CFP — 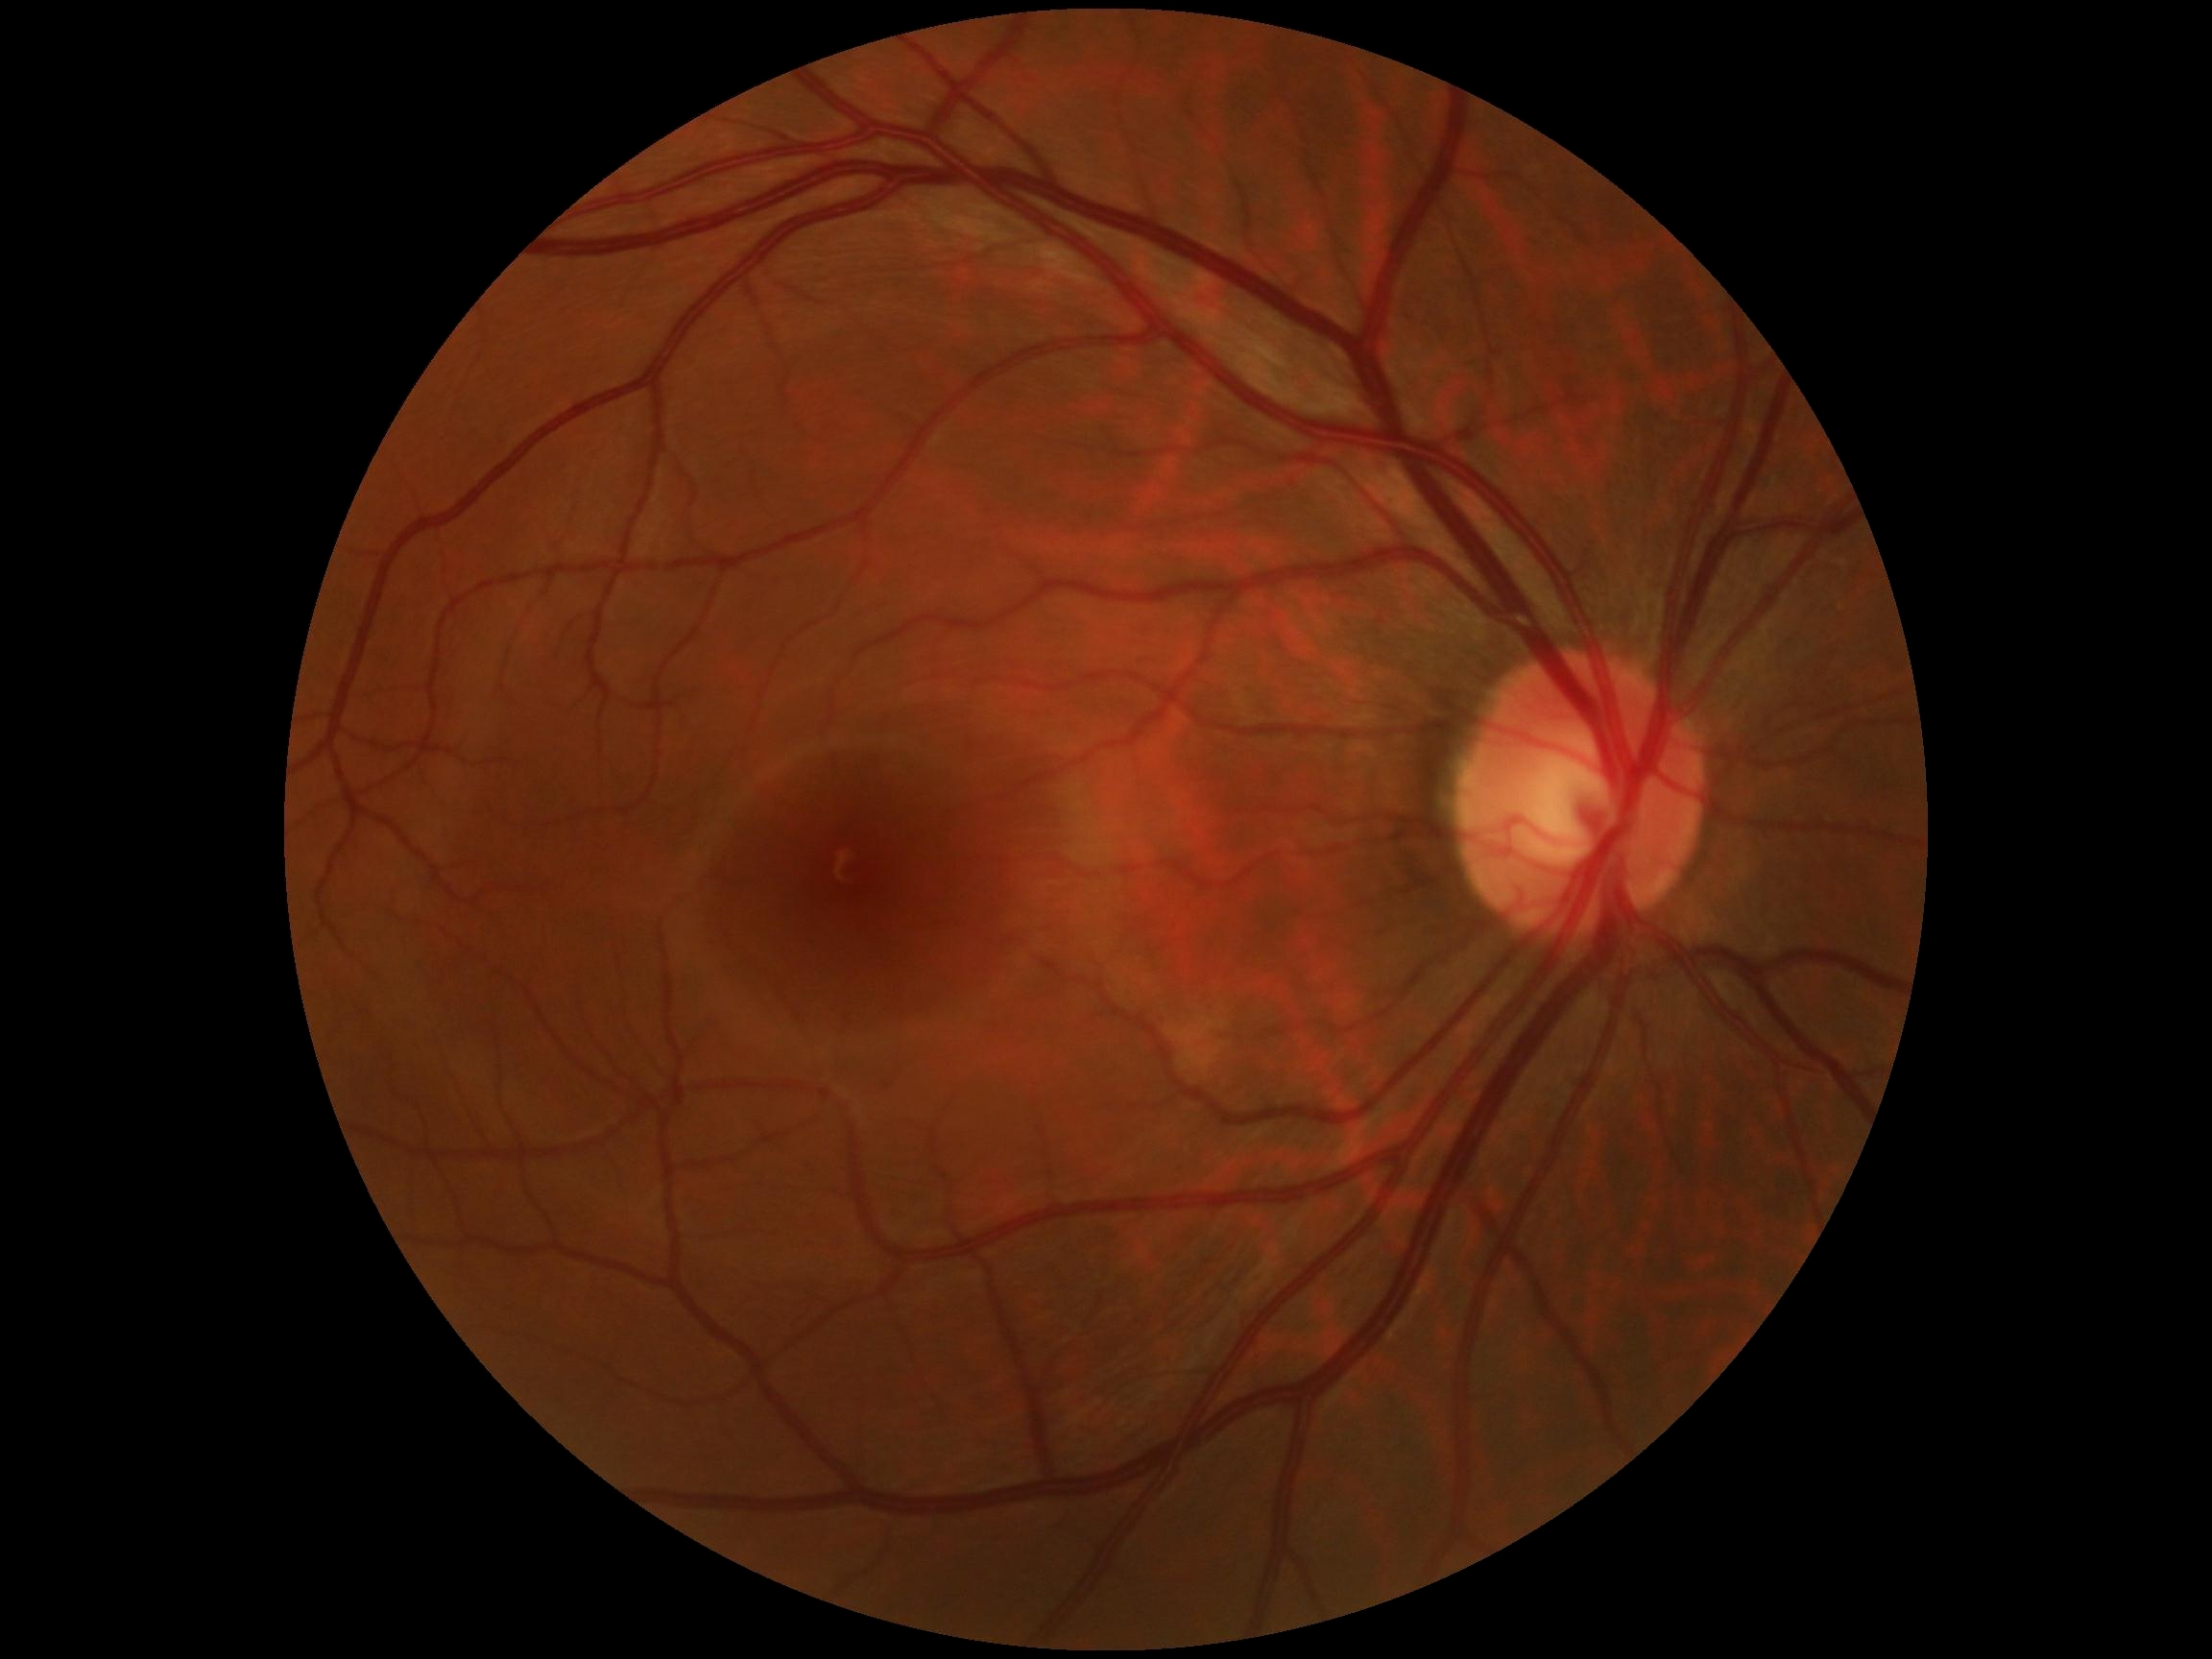
Retinopathy is no apparent diabetic retinopathy (grade 0). No signs of diabetic retinopathy.